CFP. FOV: 45 degrees. 2352x1568: 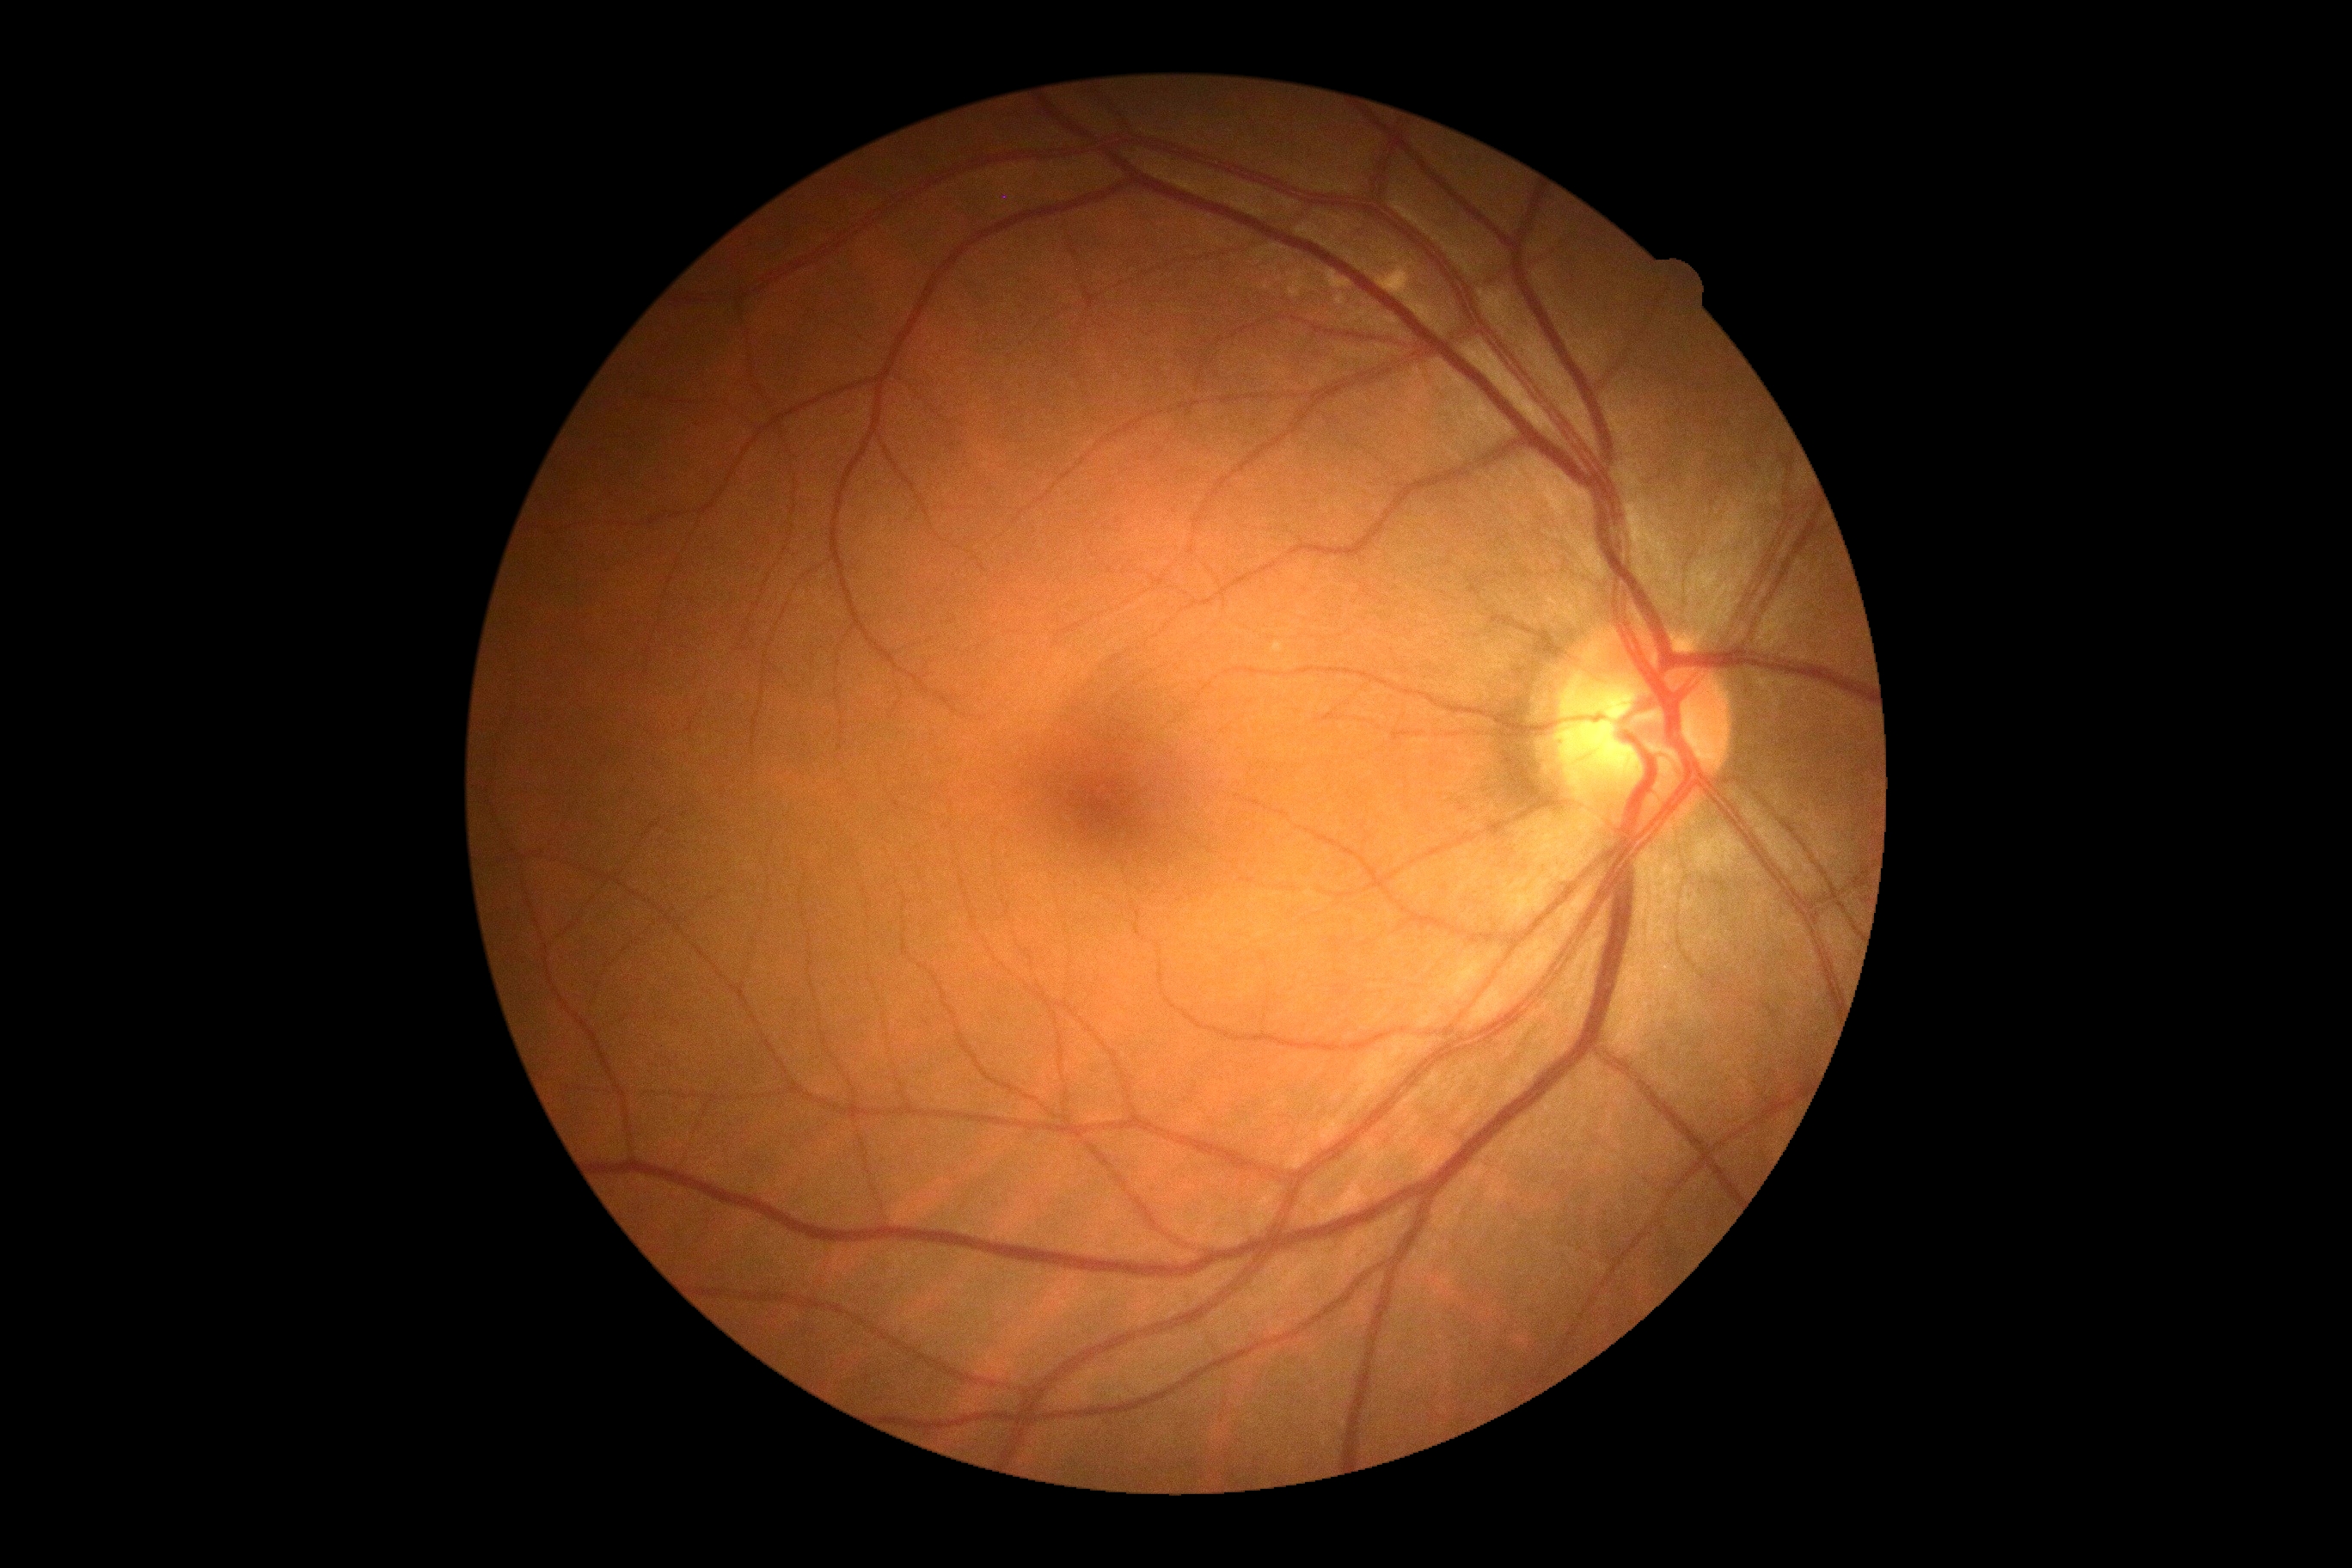
DR severity = no apparent diabetic retinopathy (grade 0).